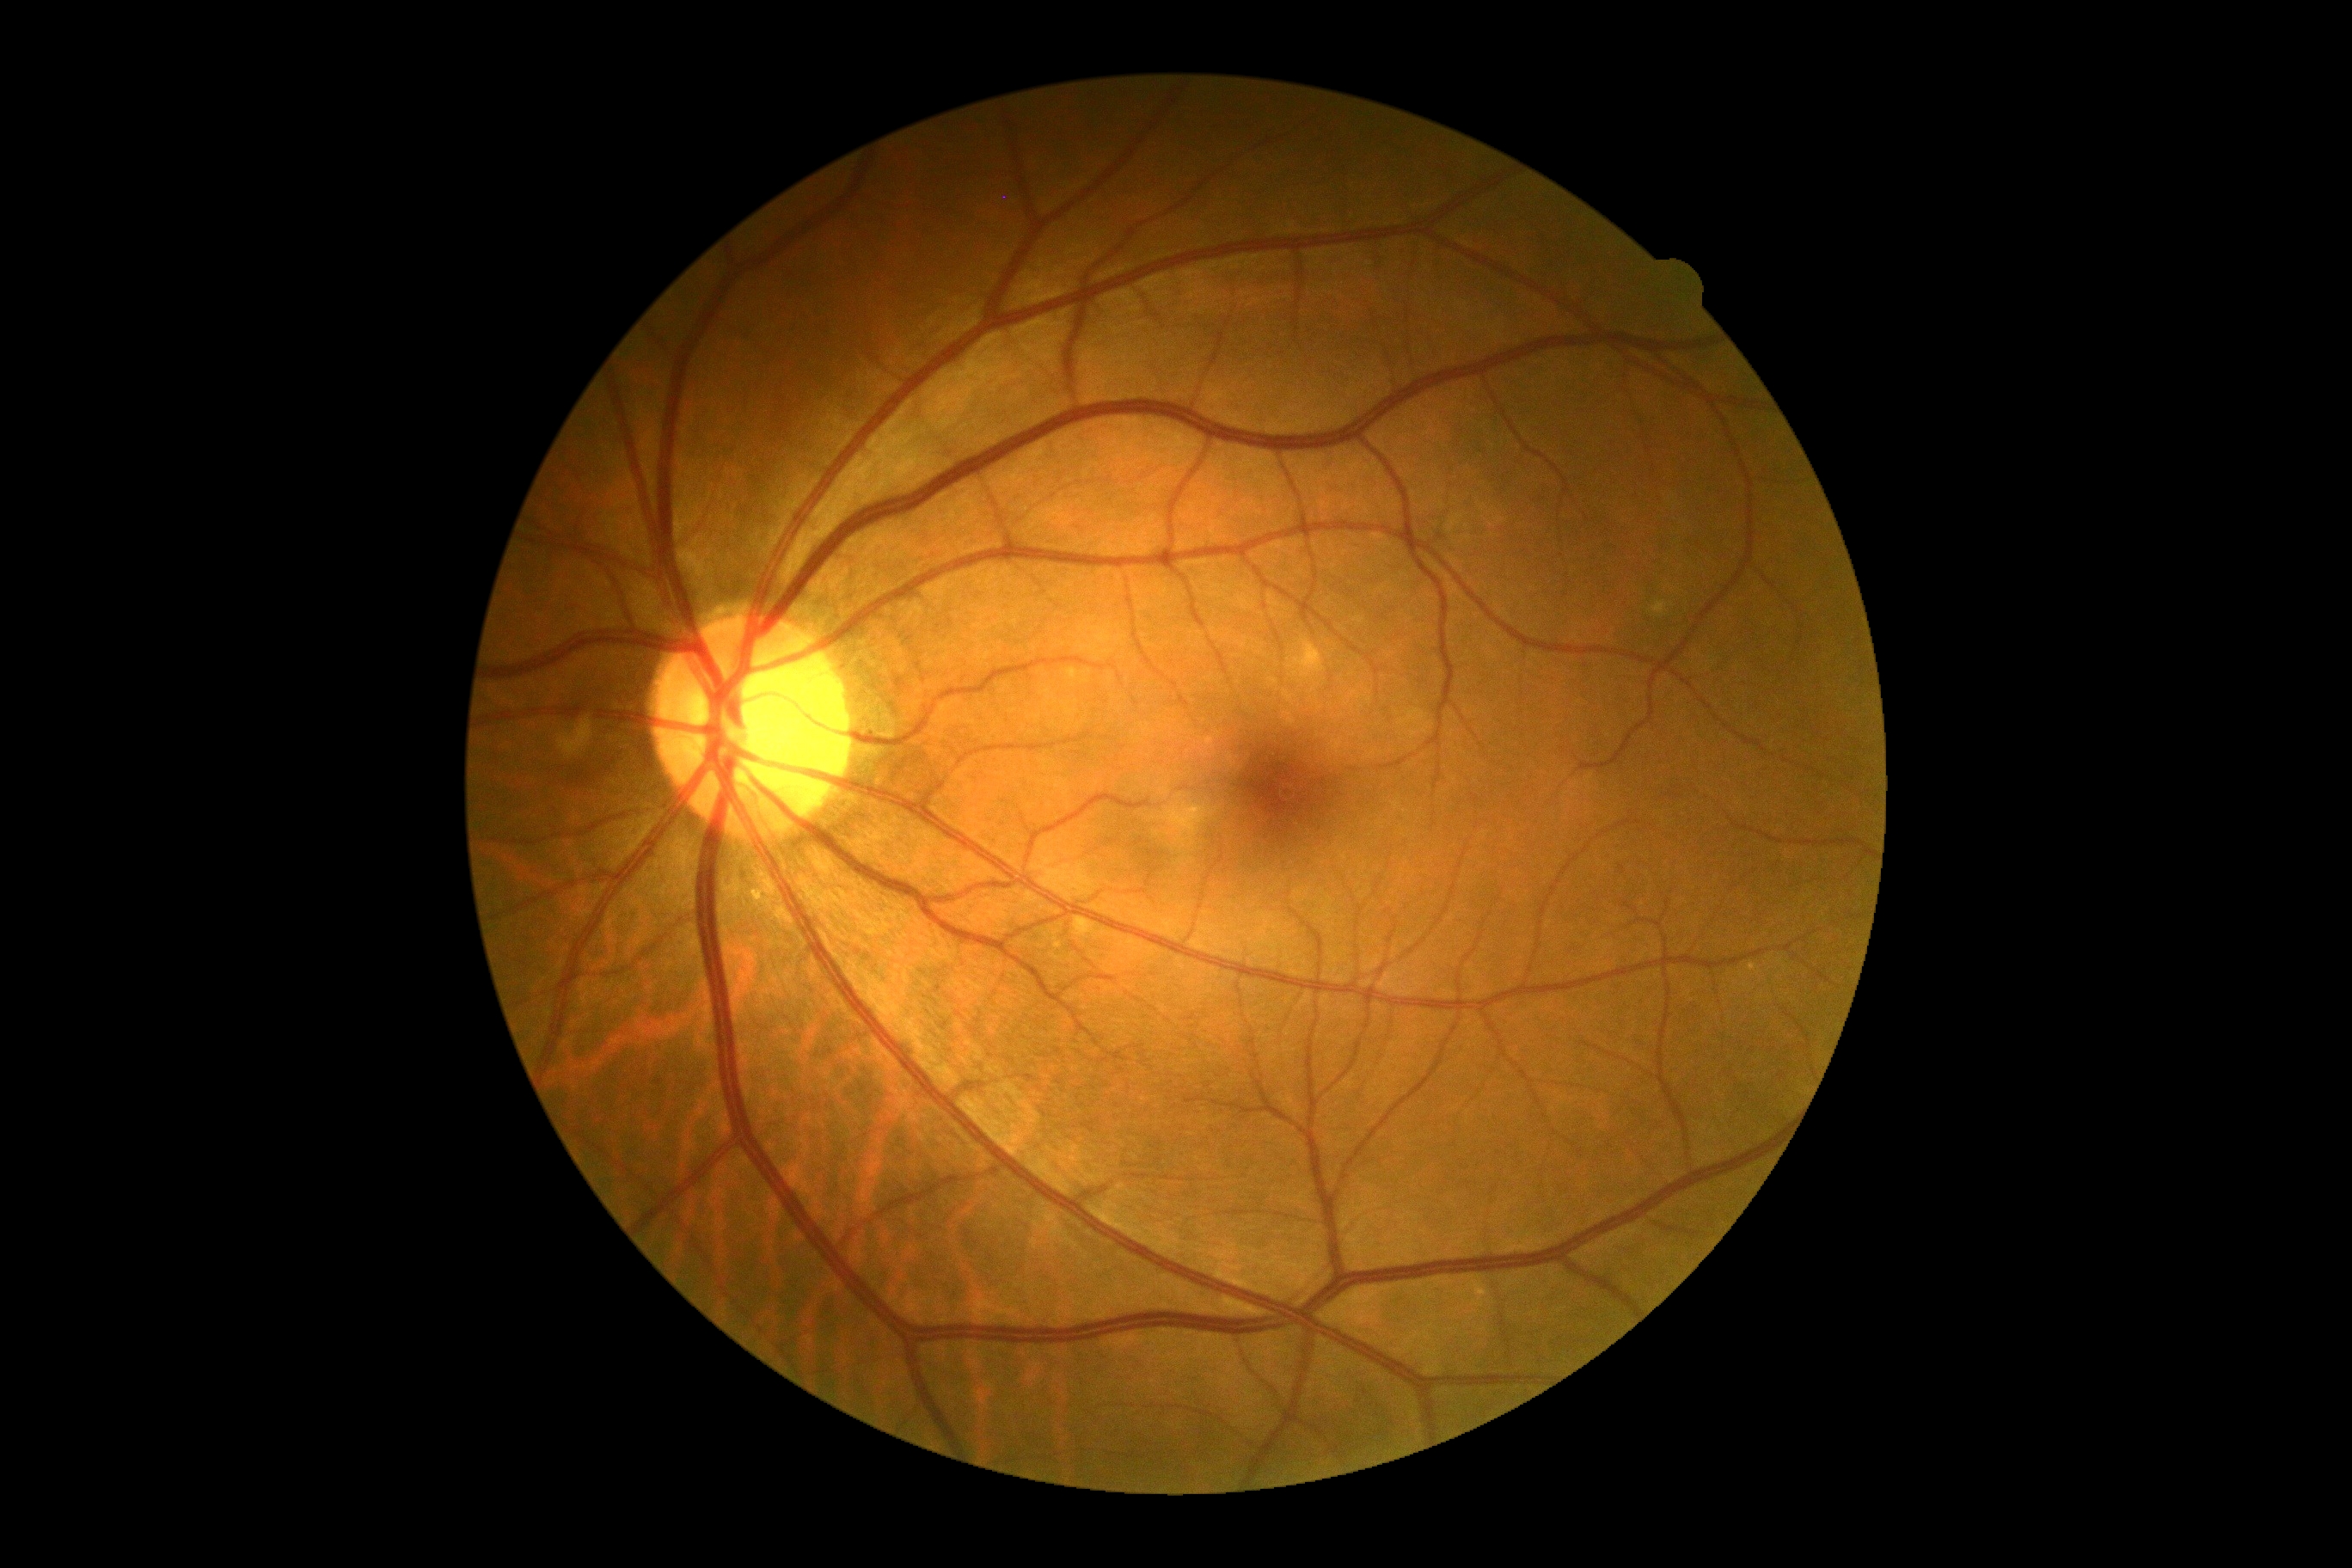 Diabetic retinopathy is 0/4 — no visible signs of diabetic retinopathy.